Wide-field fundus photograph of an infant
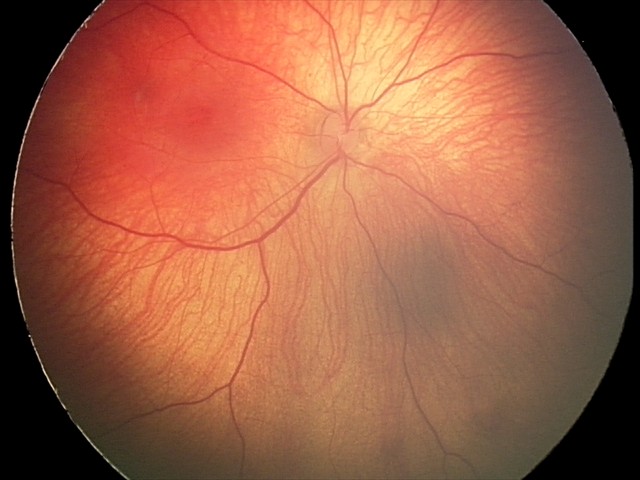 Screening series with retinal hemorrhages.